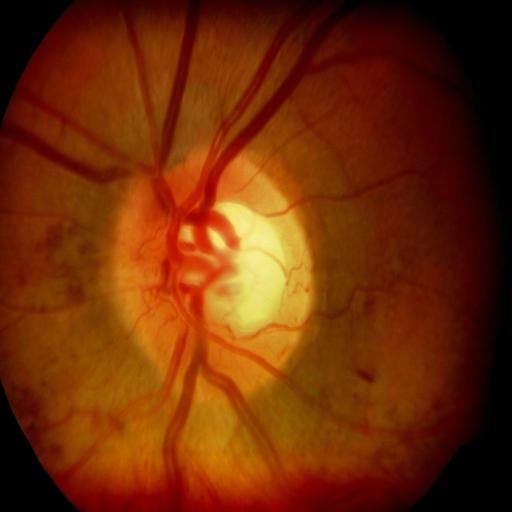

There is evidence of hemorrhagic retinopathy and optic disc cupping.